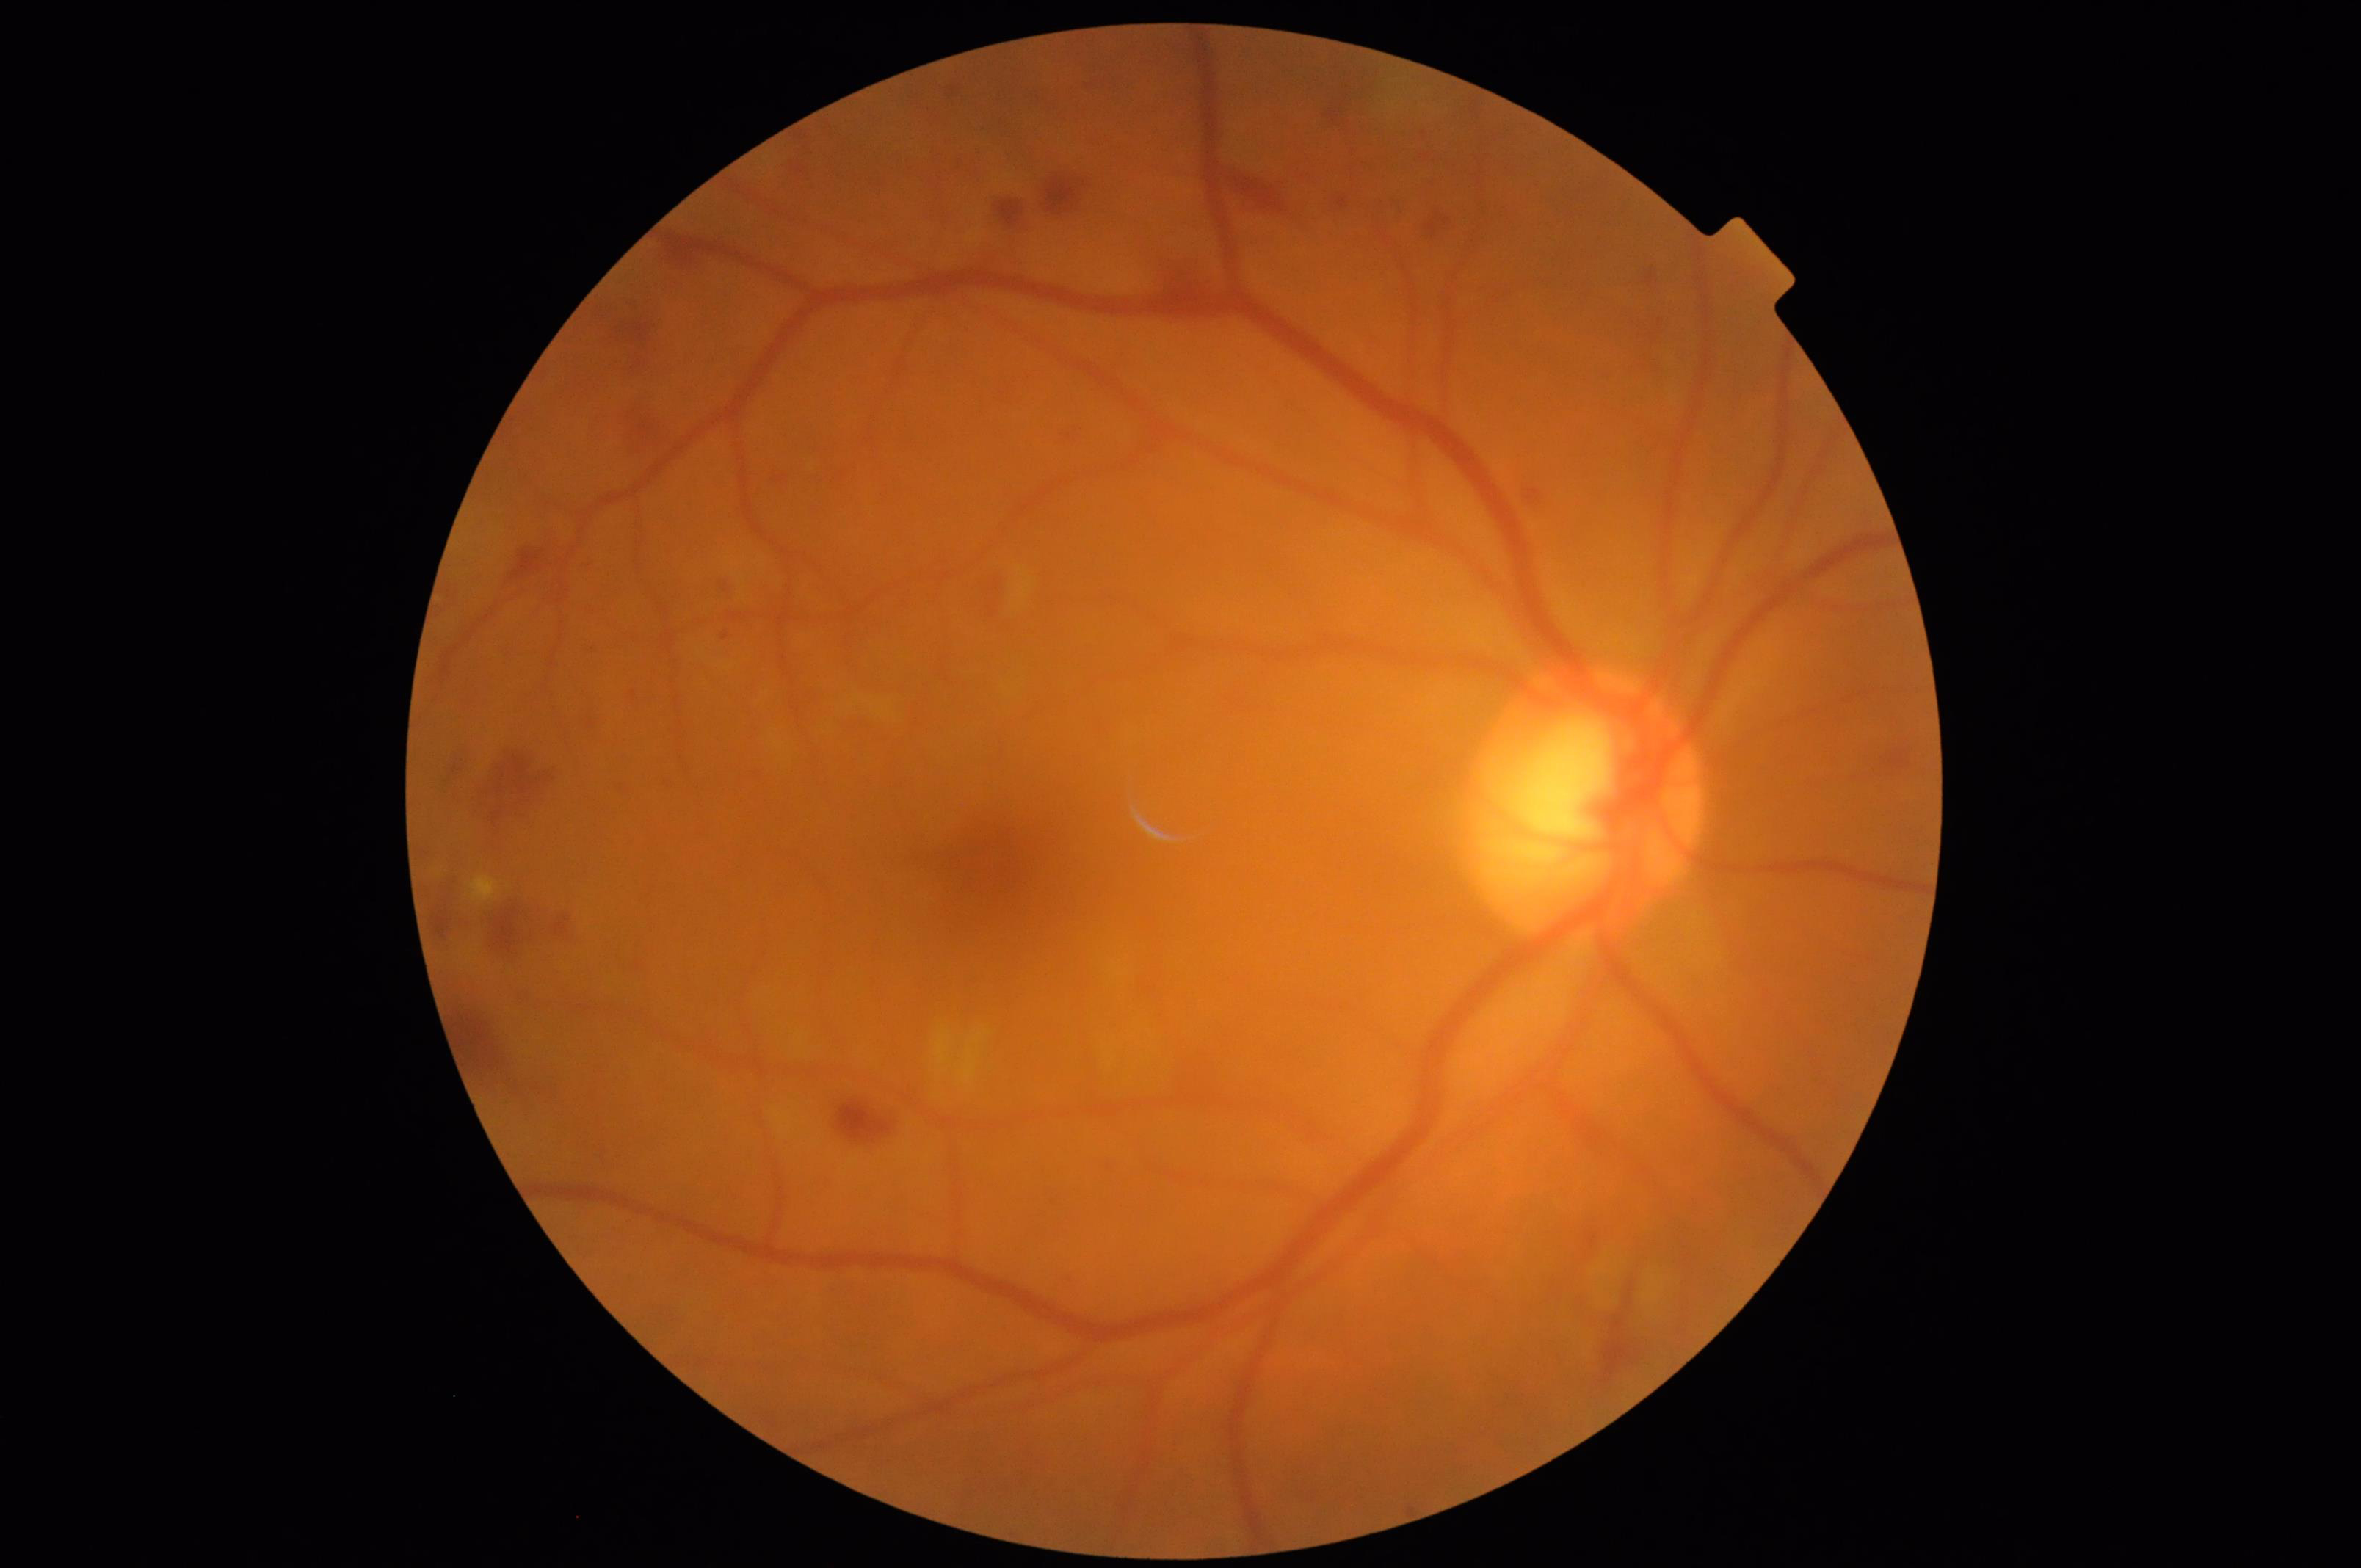 Illumination and color balance are good.
Overall quality is good and the image is gradable.